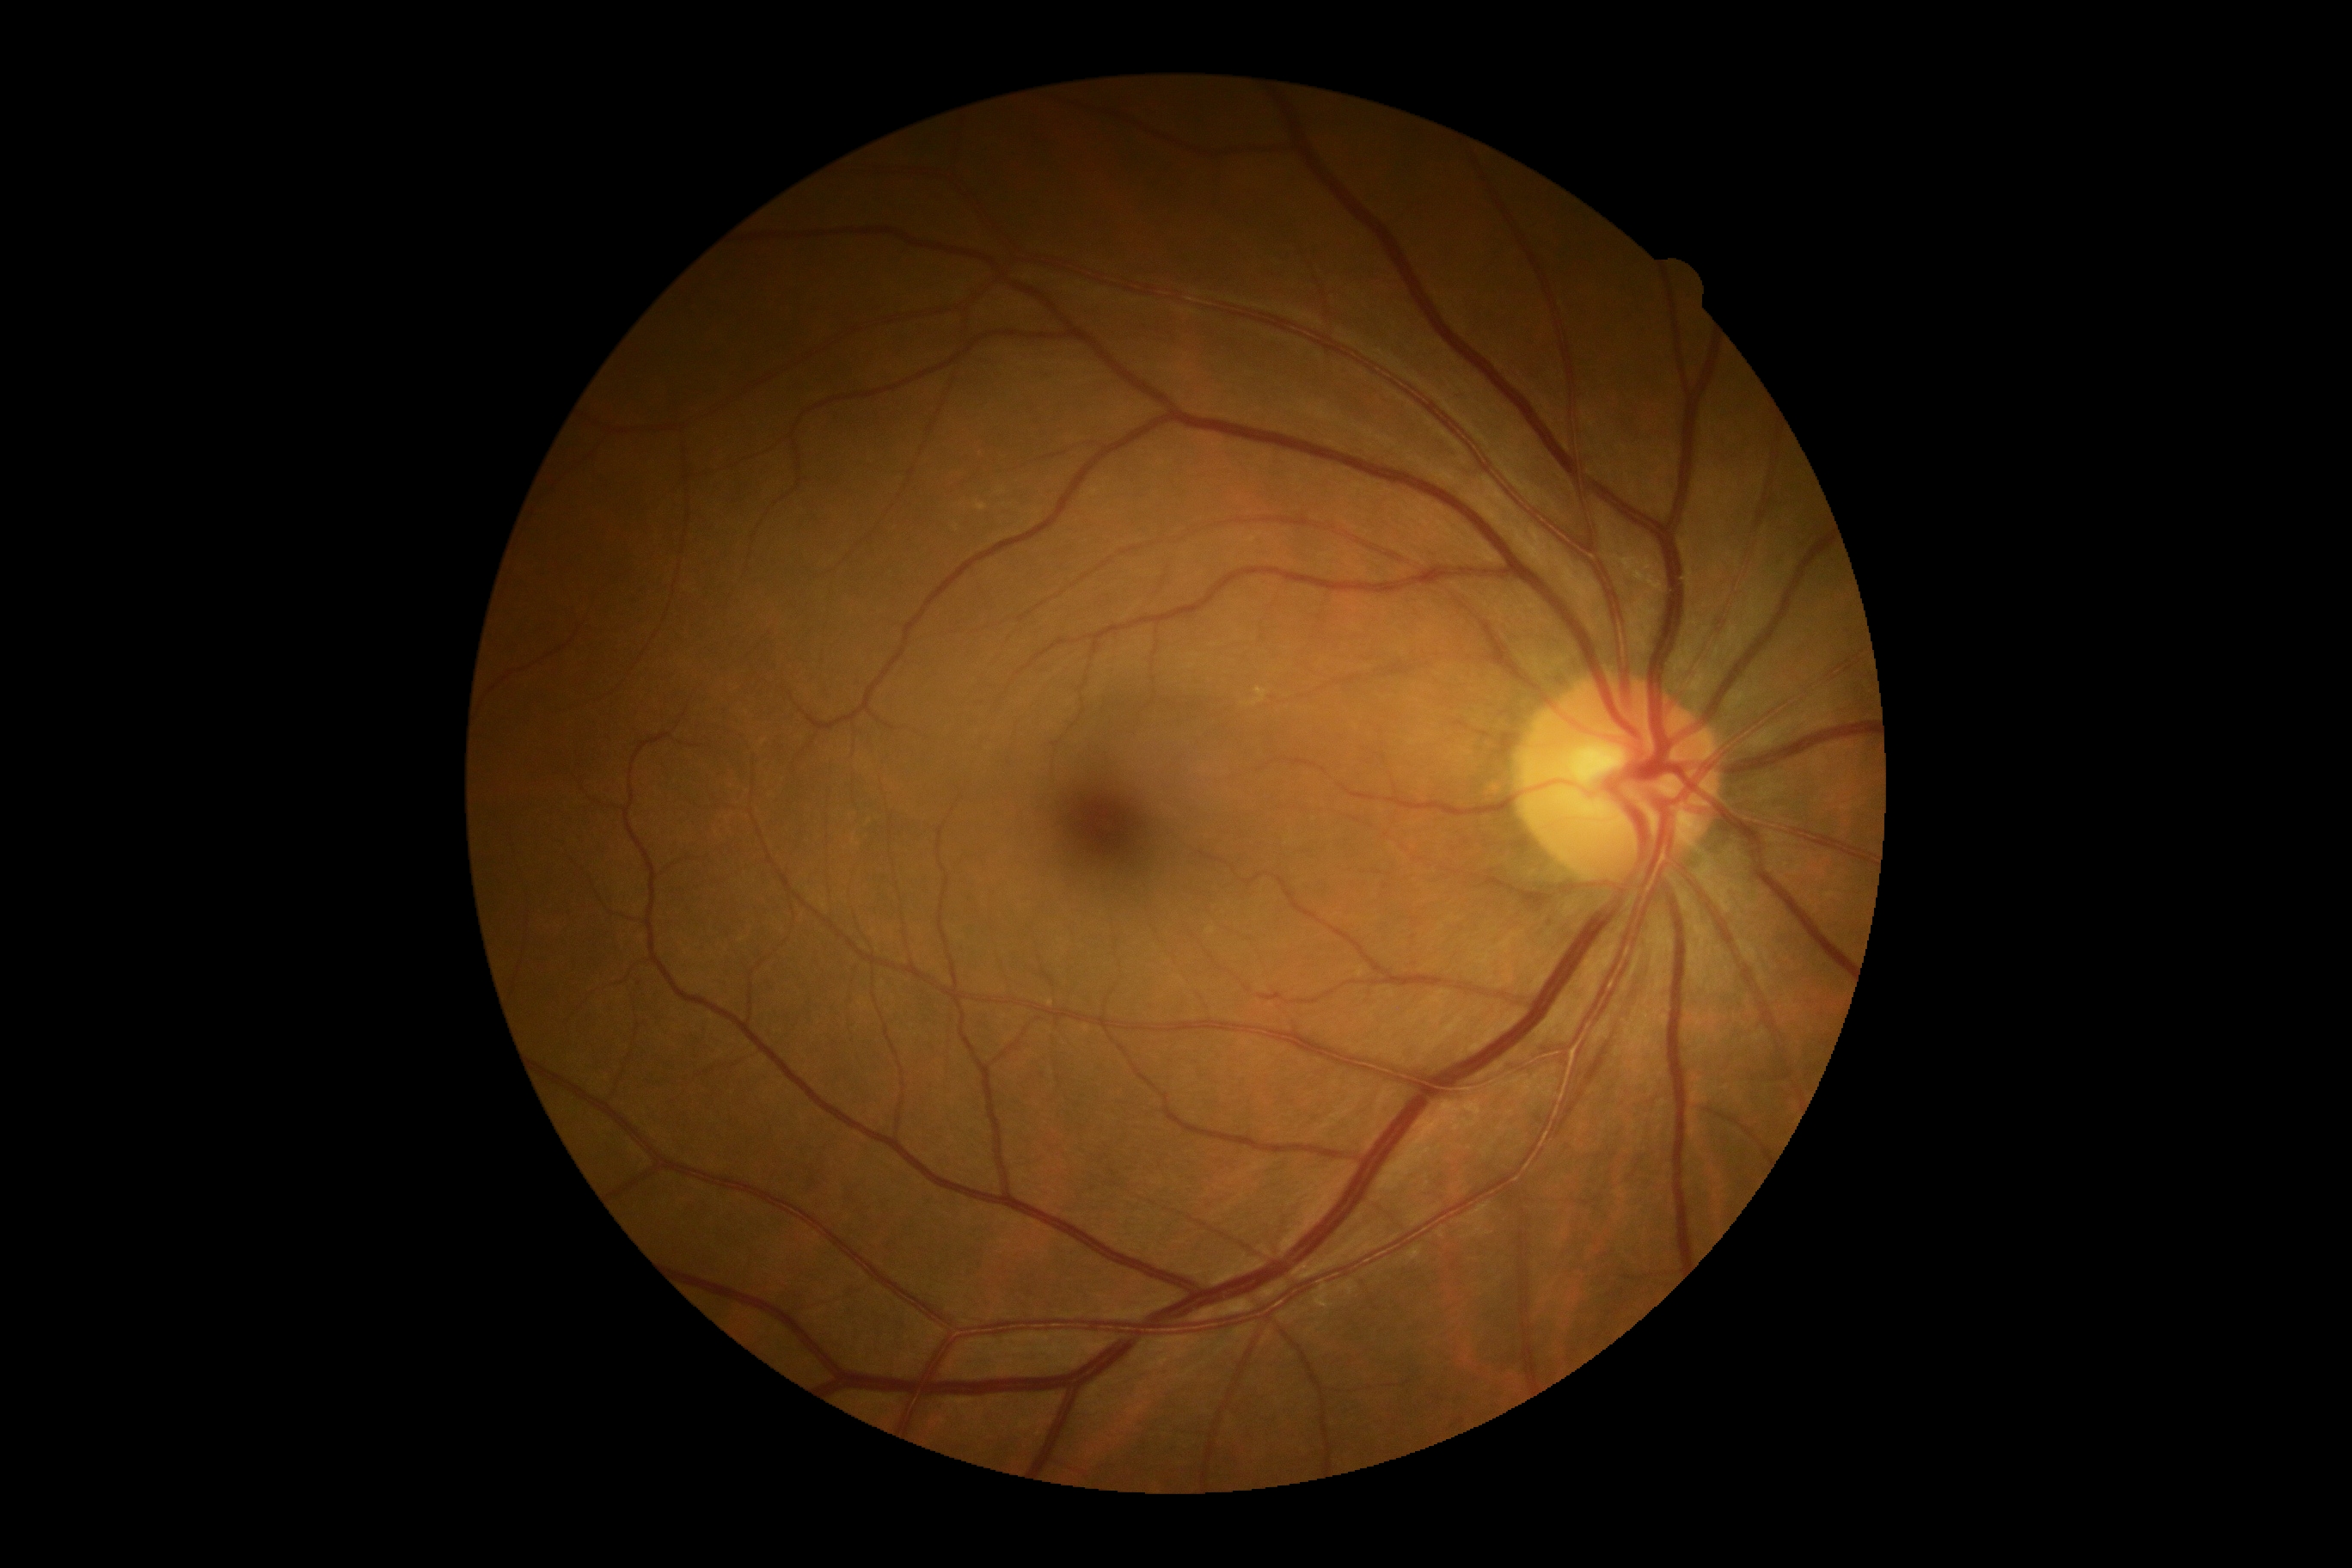 Diabetic retinopathy (DR) is 0.